45° field of view.
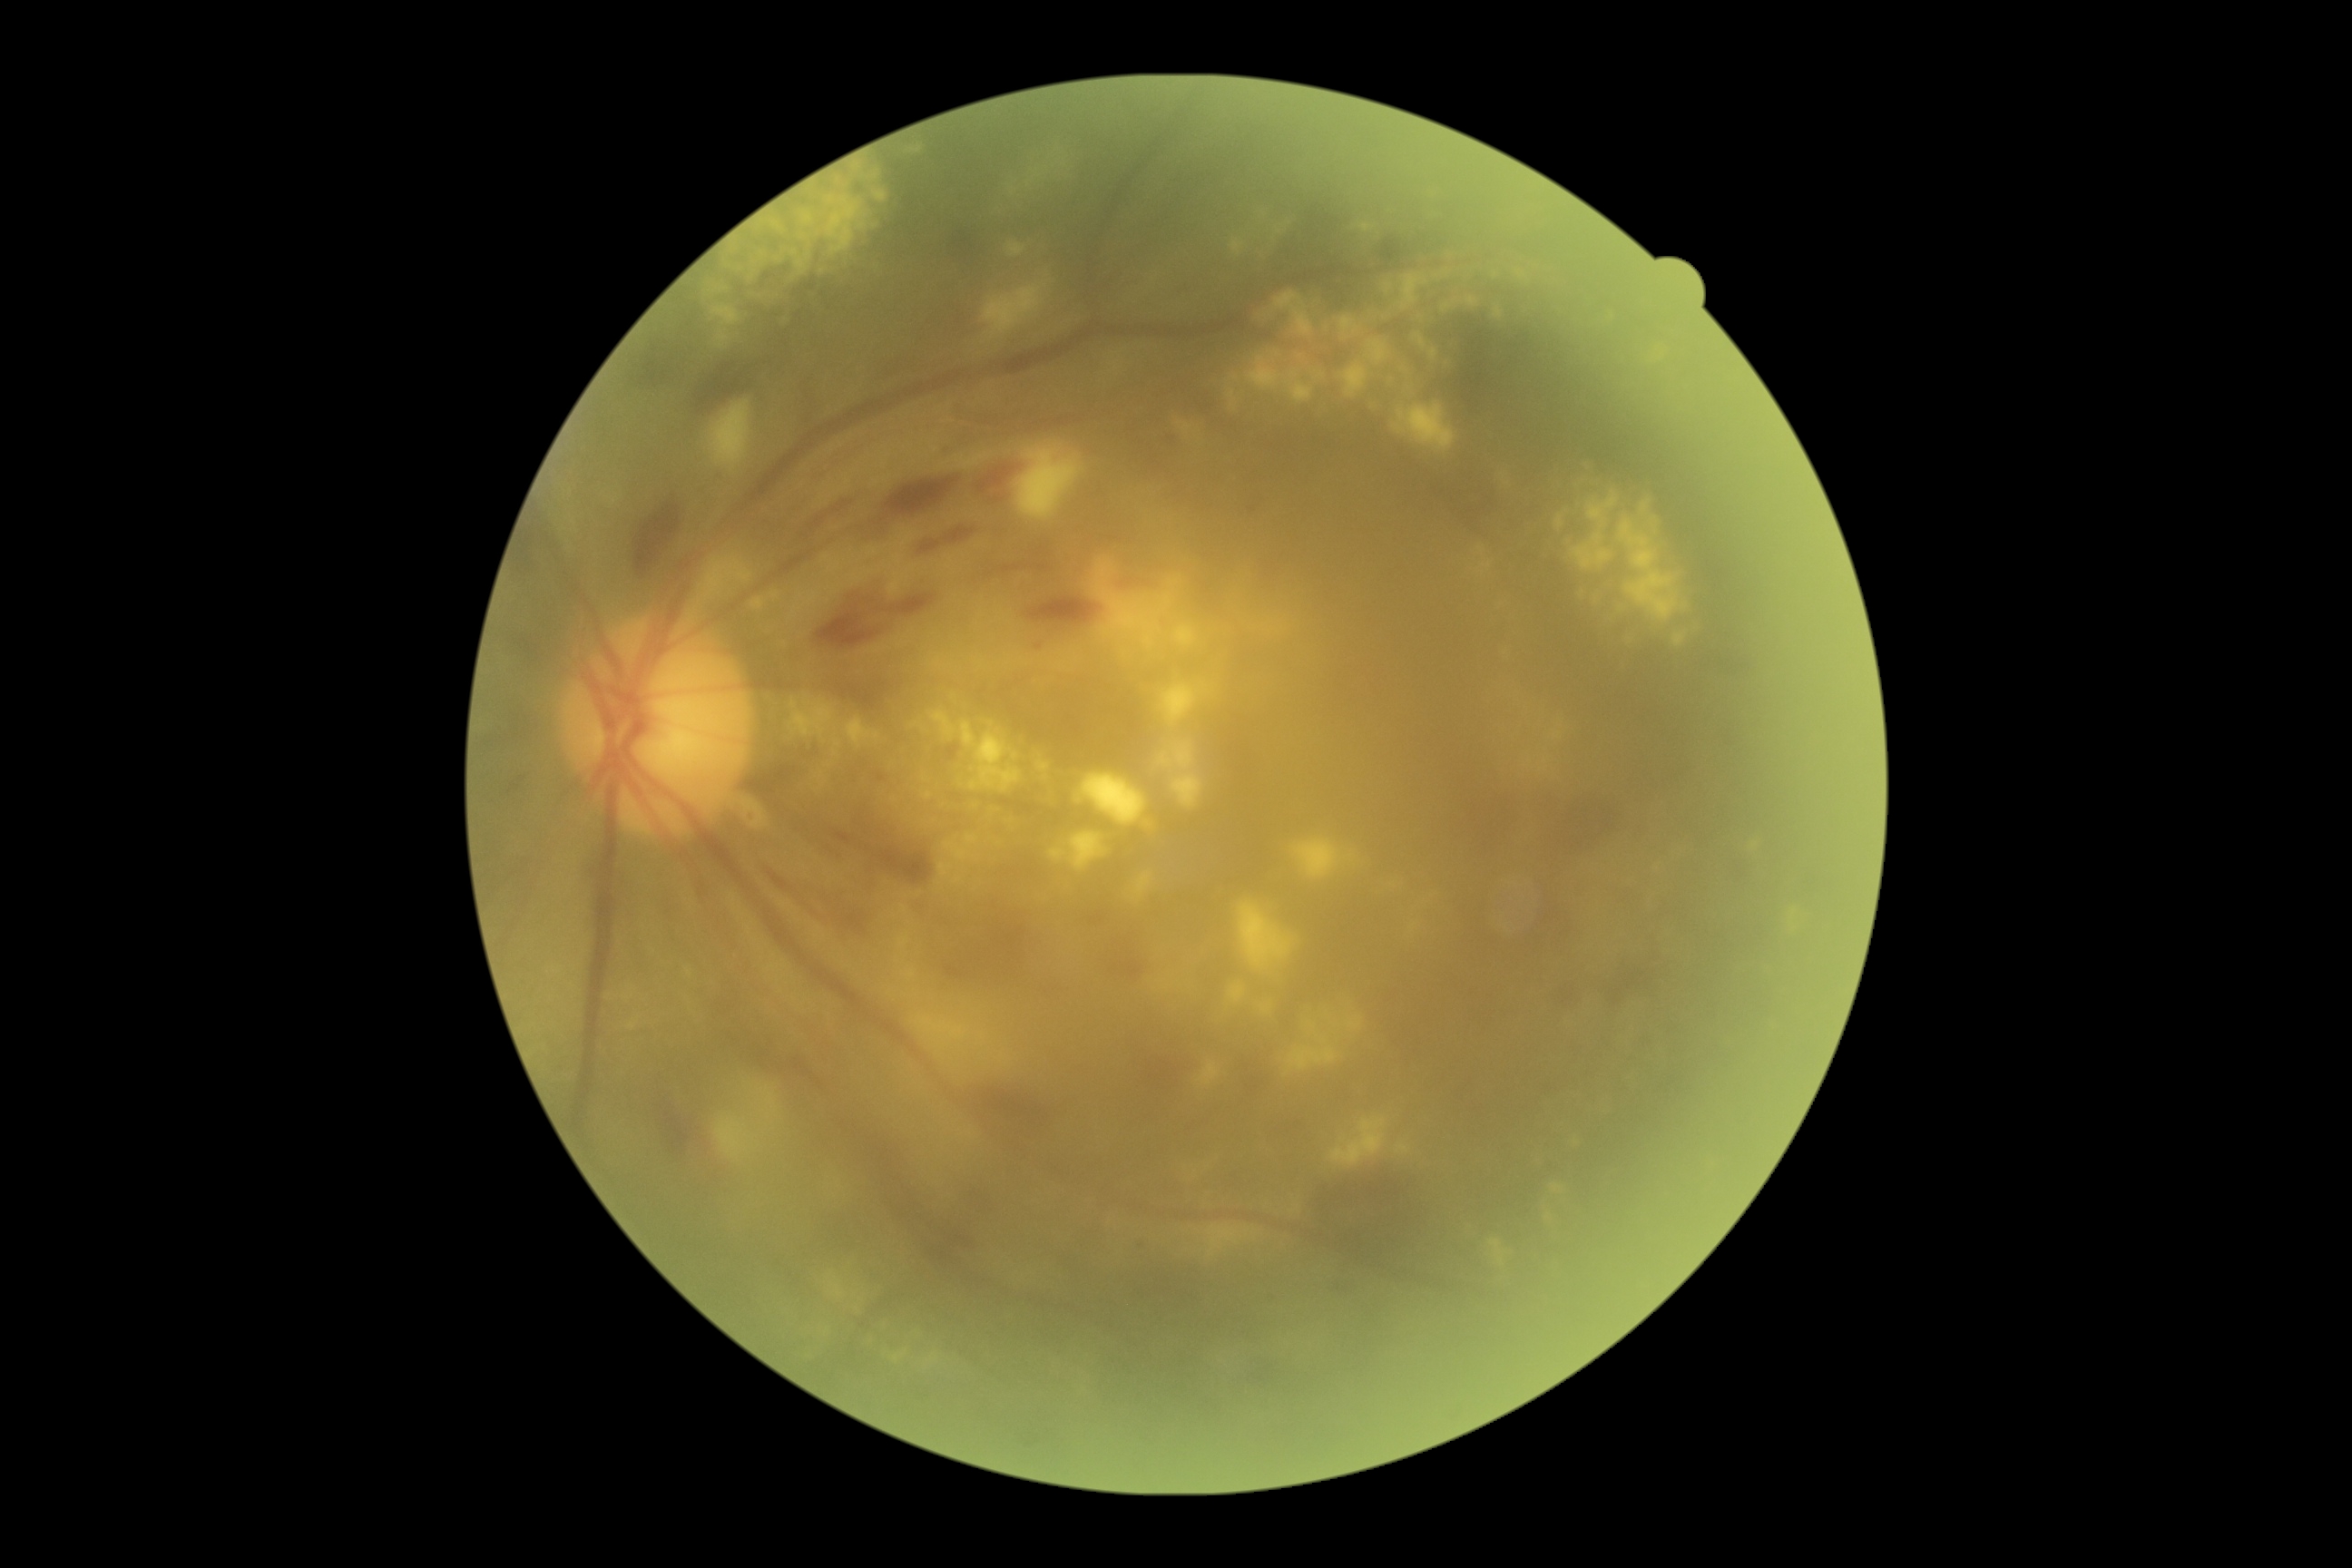 retinopathy grade = 3.